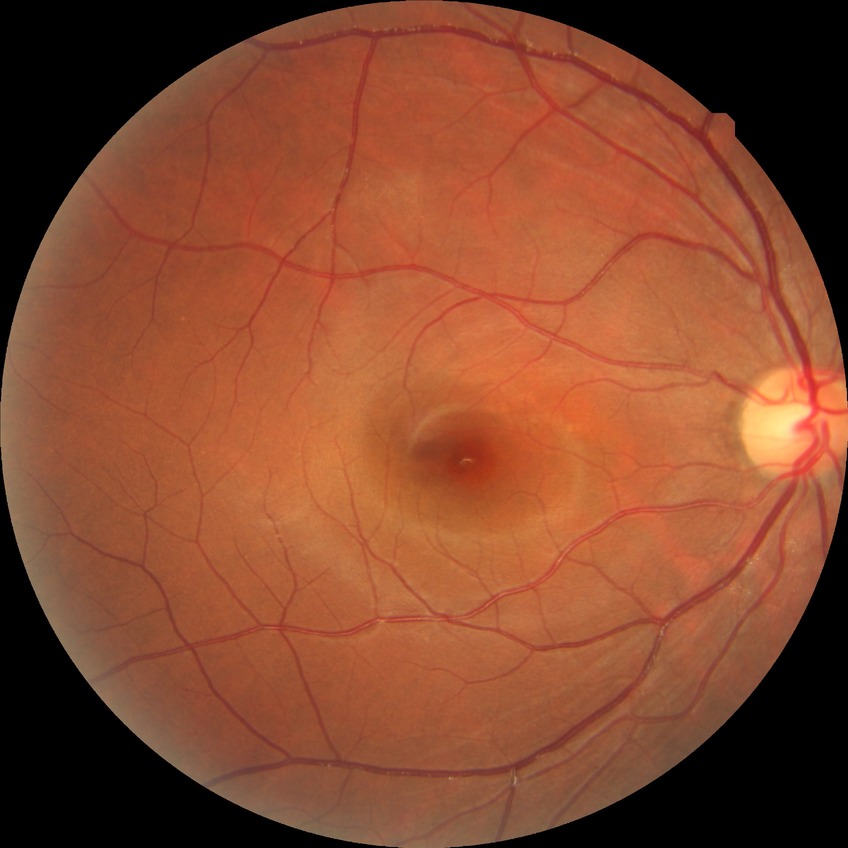 davis_grade: NDR
dr_impression: no DR findings